UWF retinal mosaic — 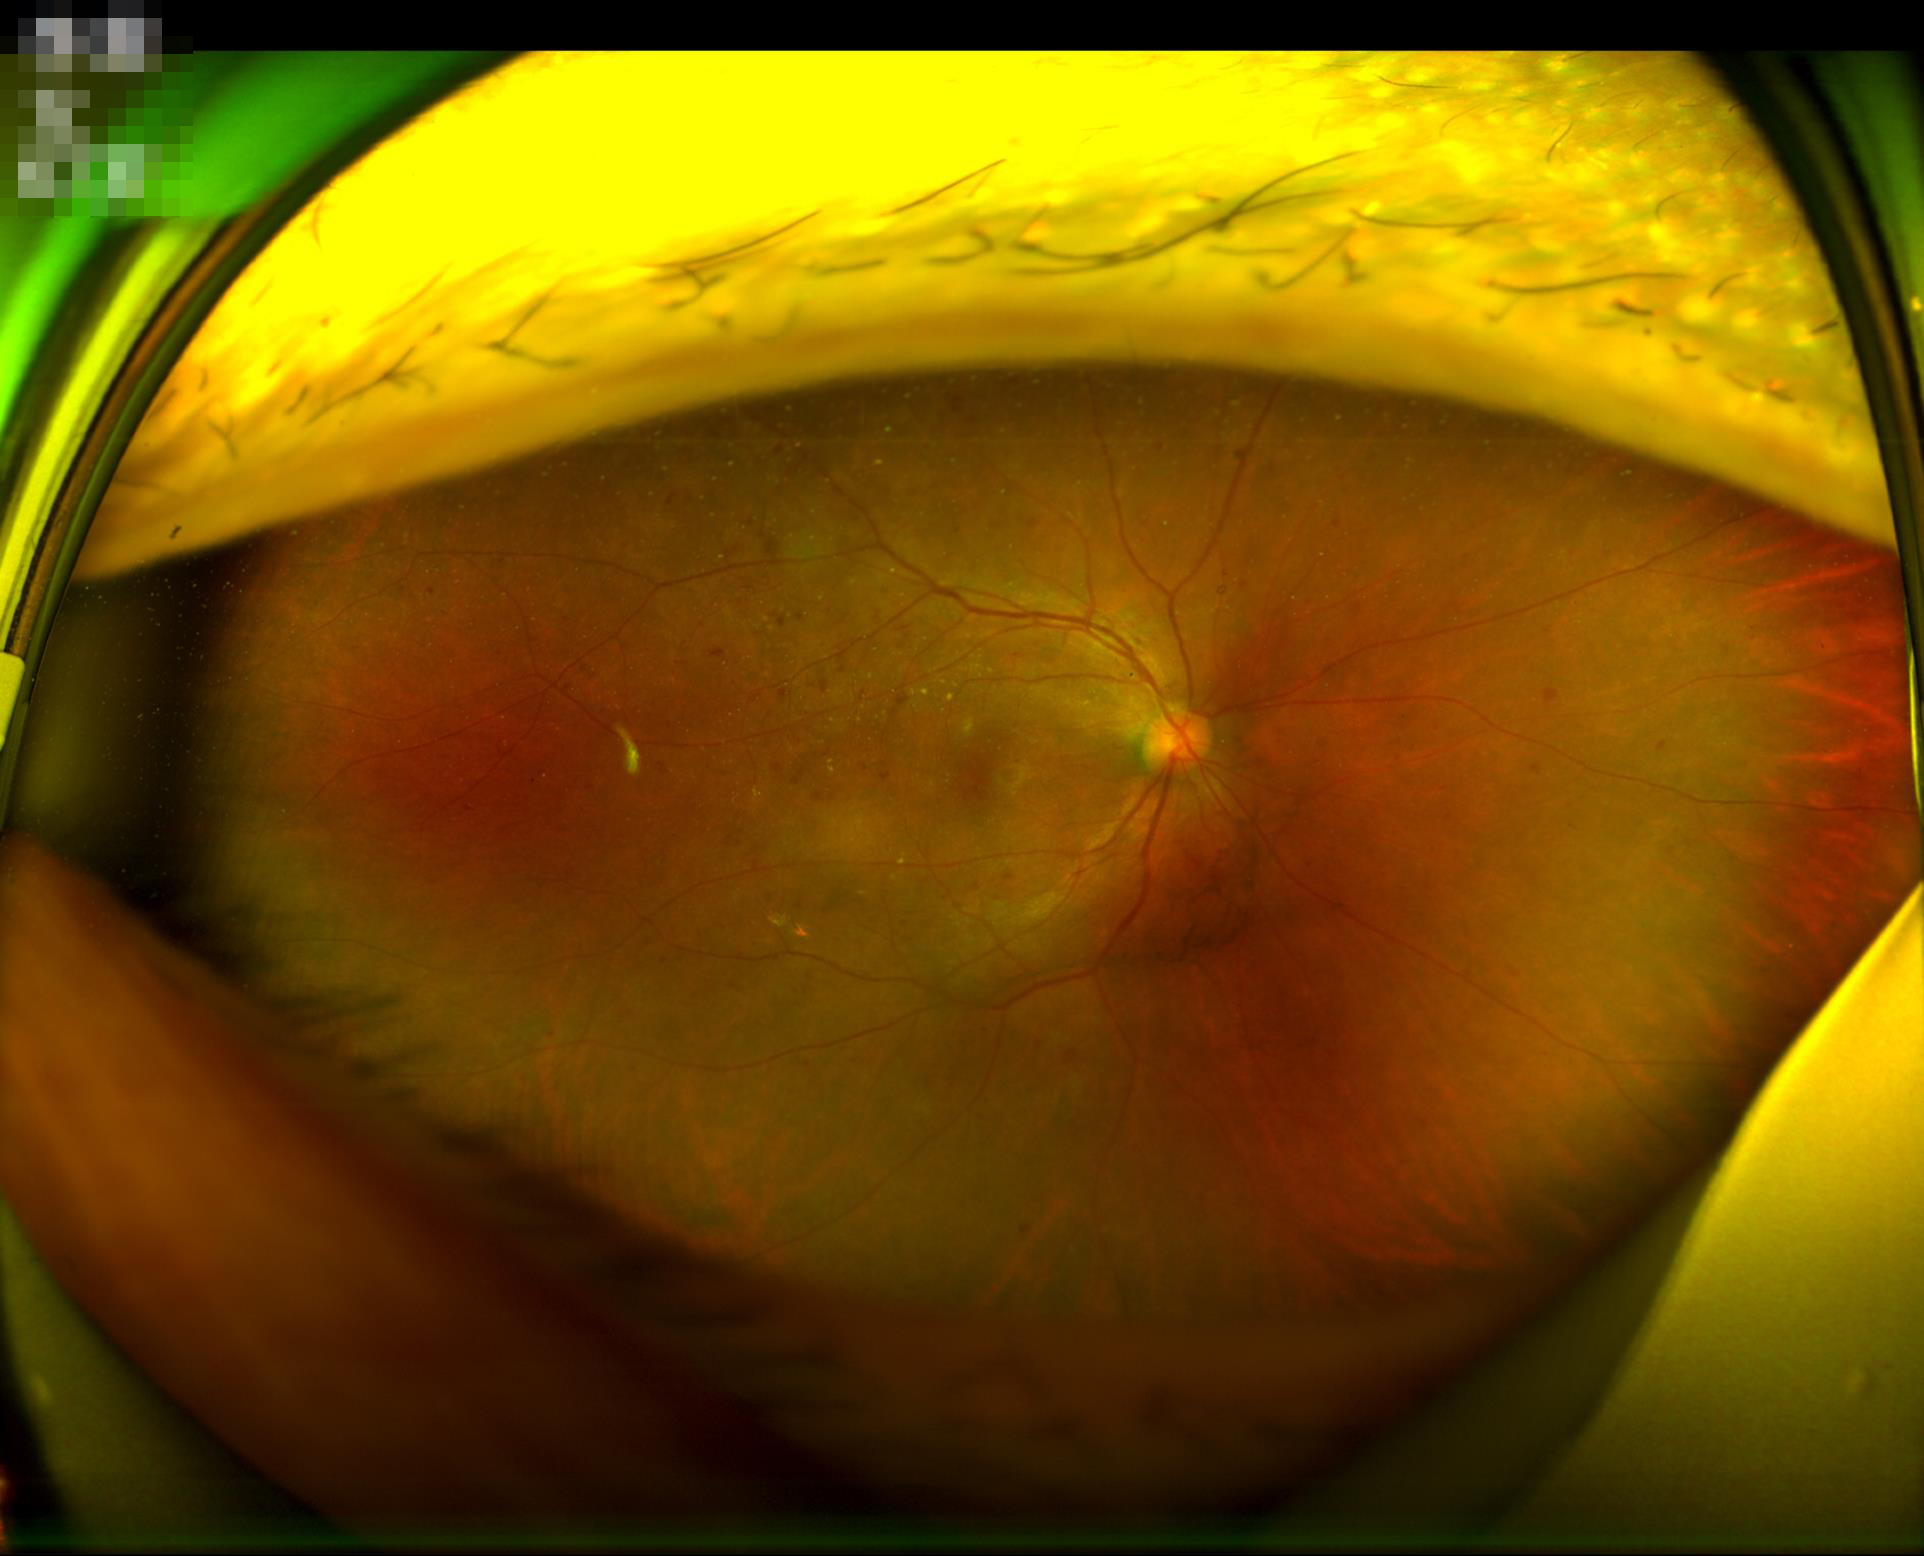 Illumination is uneven.
Acceptable image quality.
Good dynamic range.
Optic disc, vessels, and background are in focus.